Portable fundus camera image. 60° field of view: 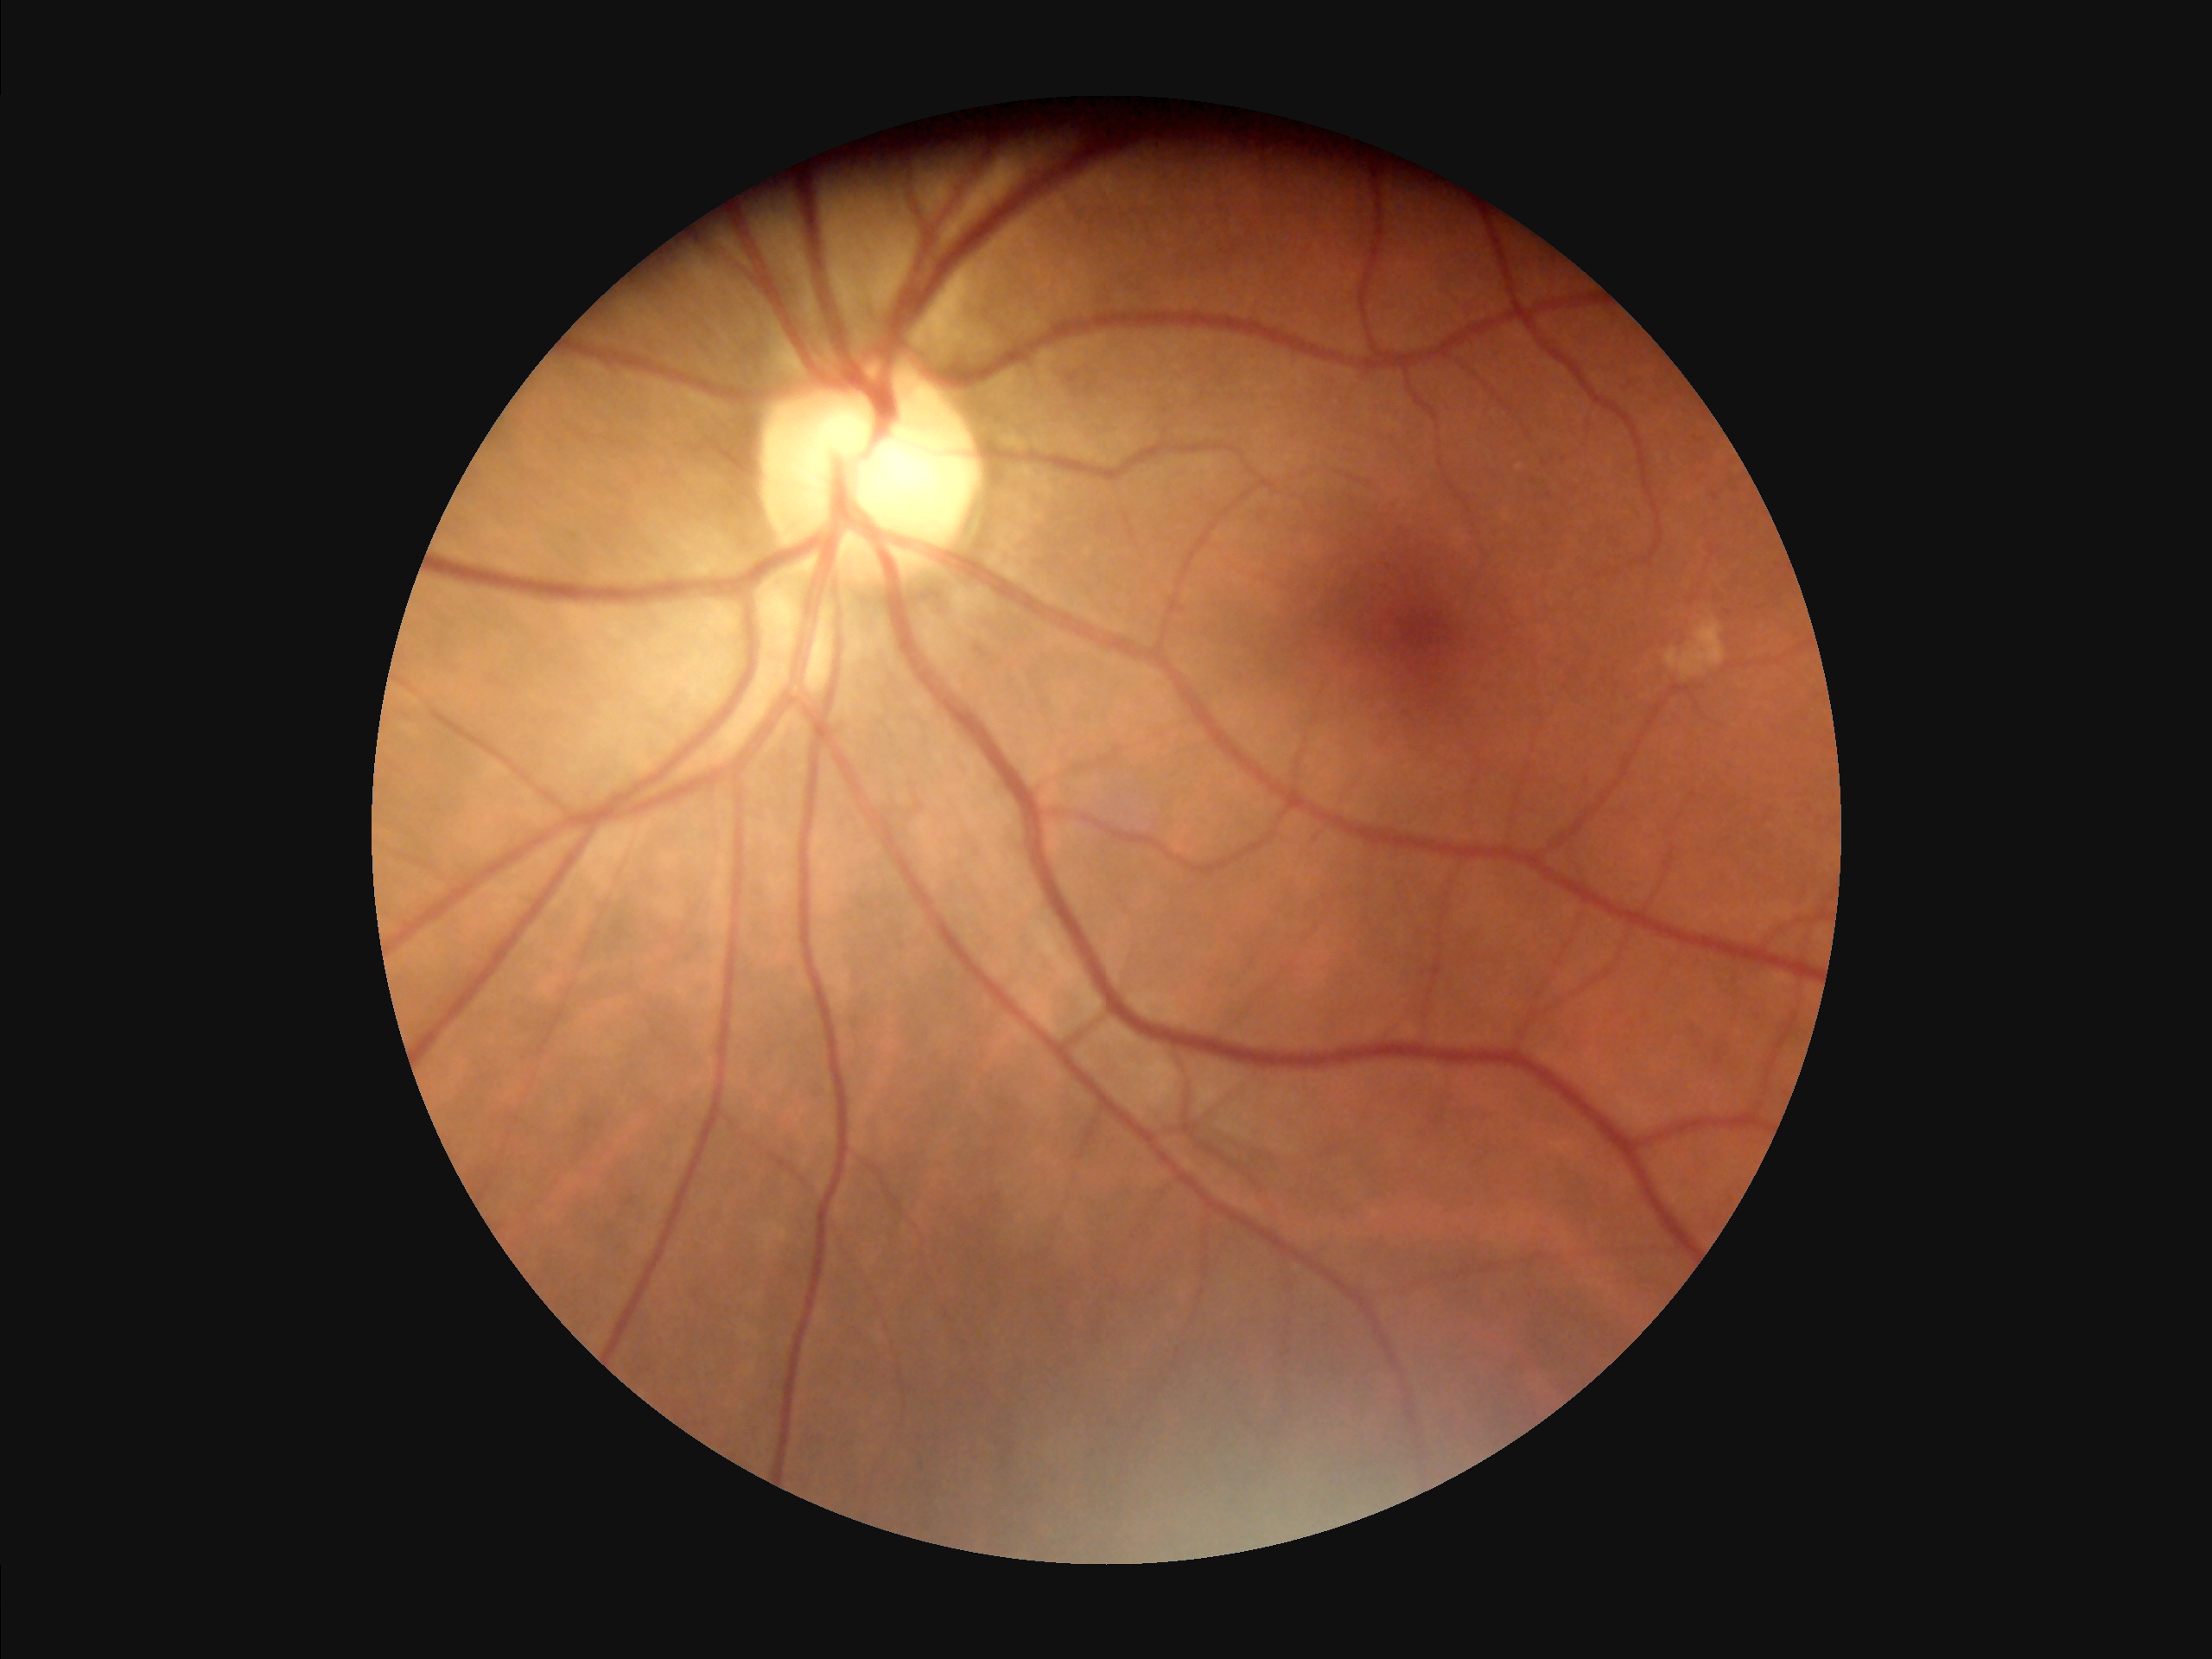

Image is sharp throughout the field. Contrast is good. Image quality is adequate for diagnostic use. Illumination is even.